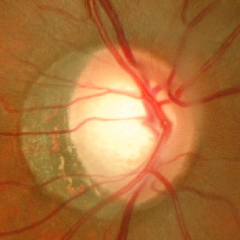
There is evidence of early-stage glaucoma.